Color fundus photograph
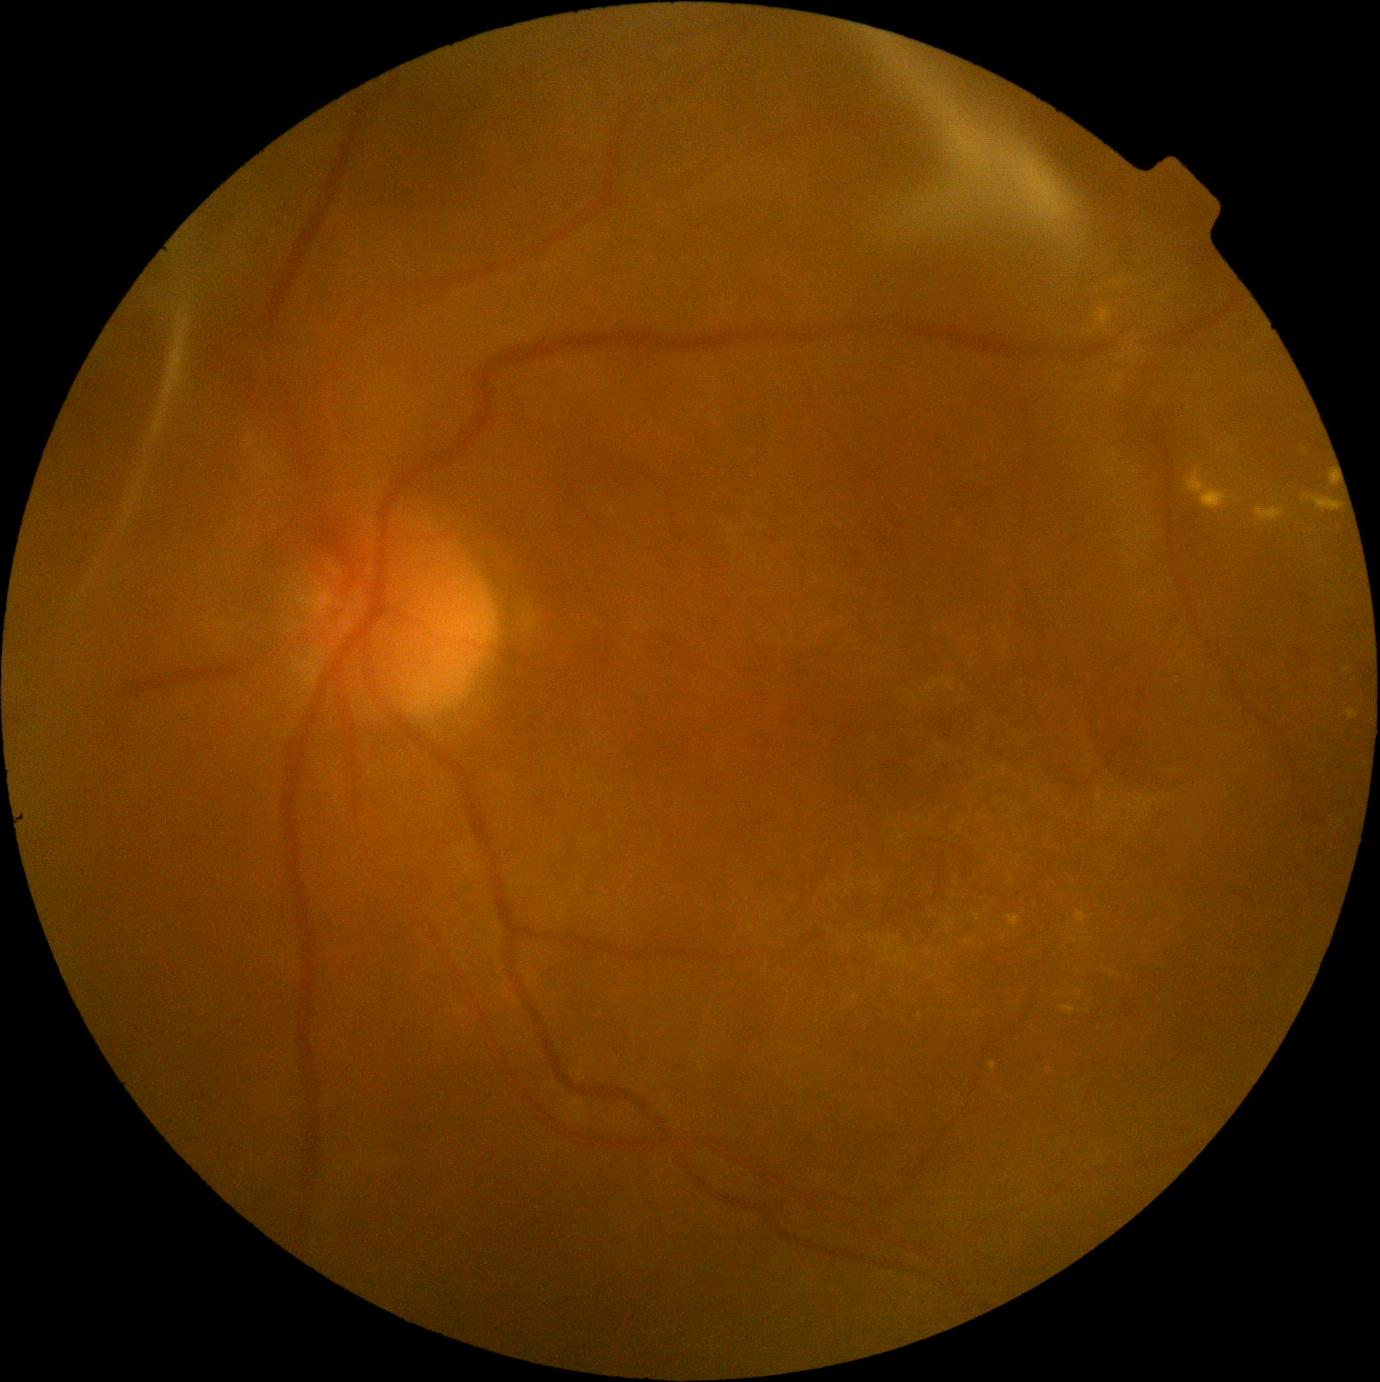

DR is proliferative diabetic retinopathy (grade 4).
Disease class: proliferative diabetic retinopathy.